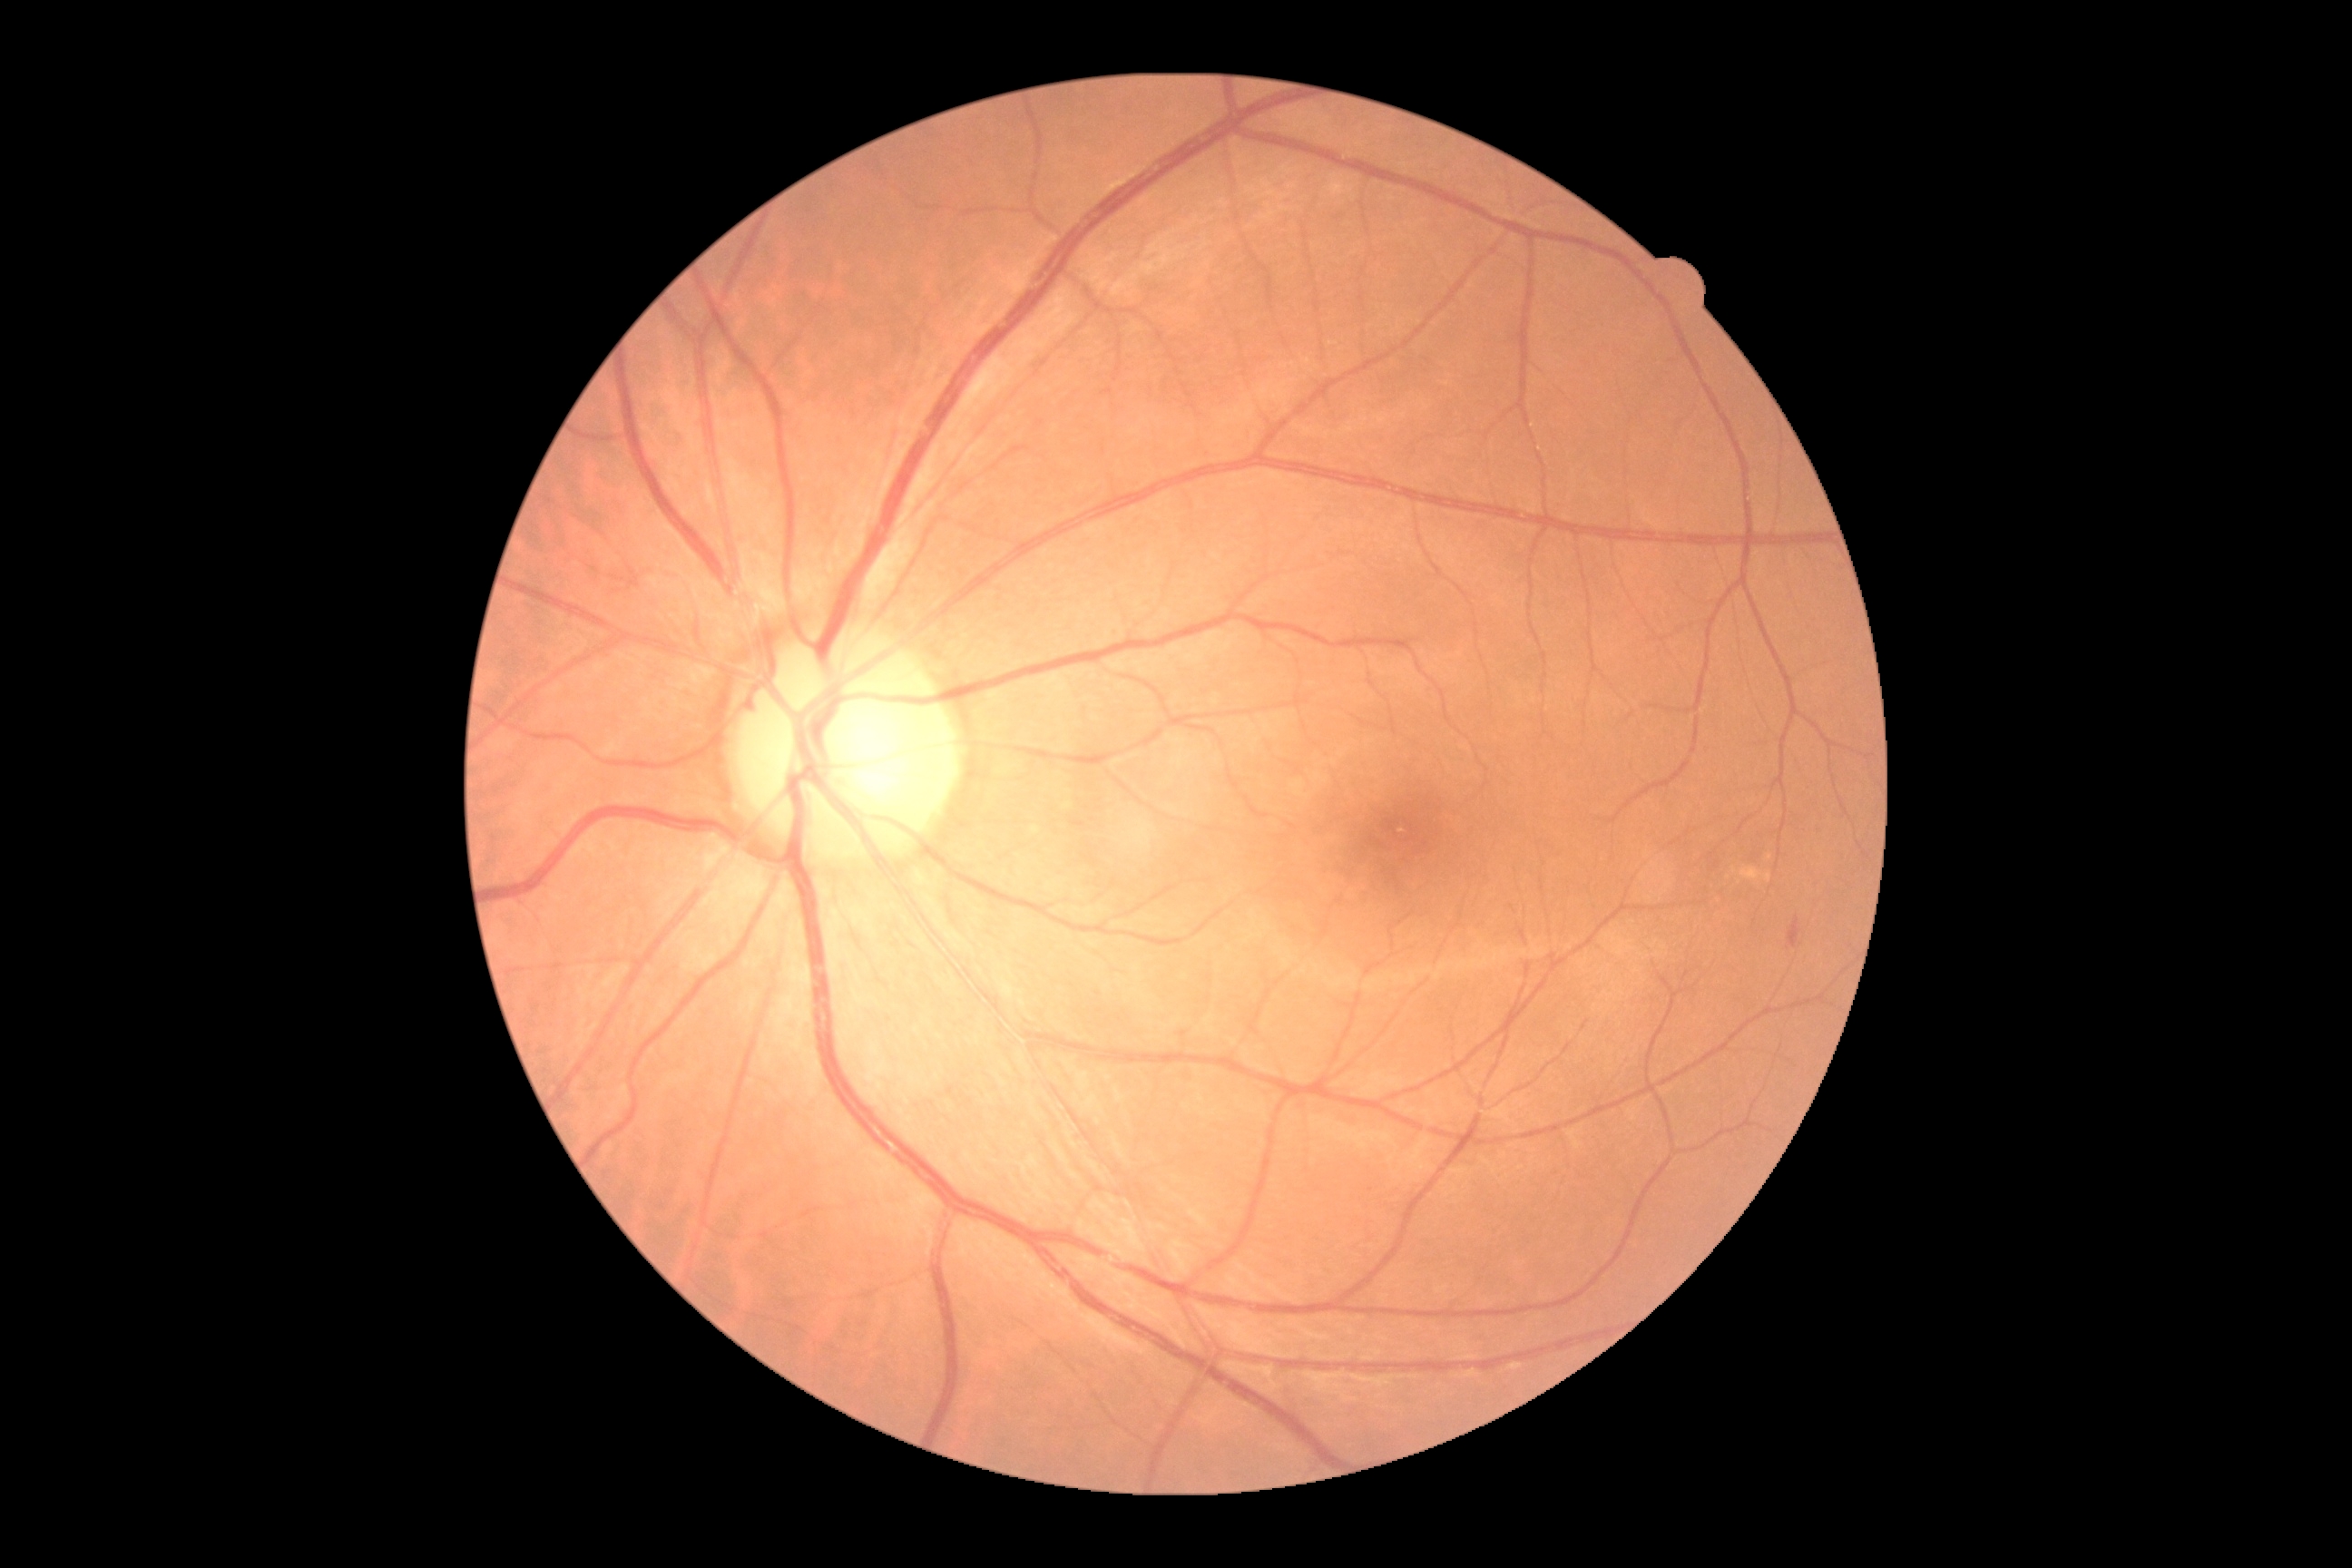

diabetic retinopathy grade = 2 — more than just microaneurysms but less than severe NPDR.